Color fundus photograph. Nonmydriatic fundus photograph — 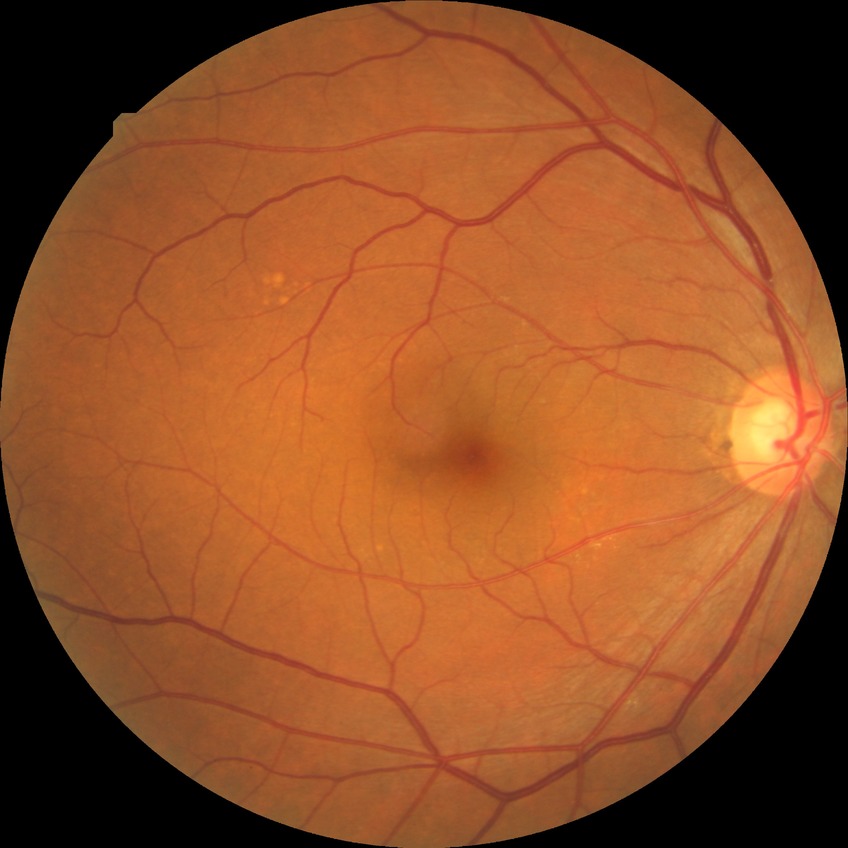
Assessment:
• retinopathy stage — no diabetic retinopathy